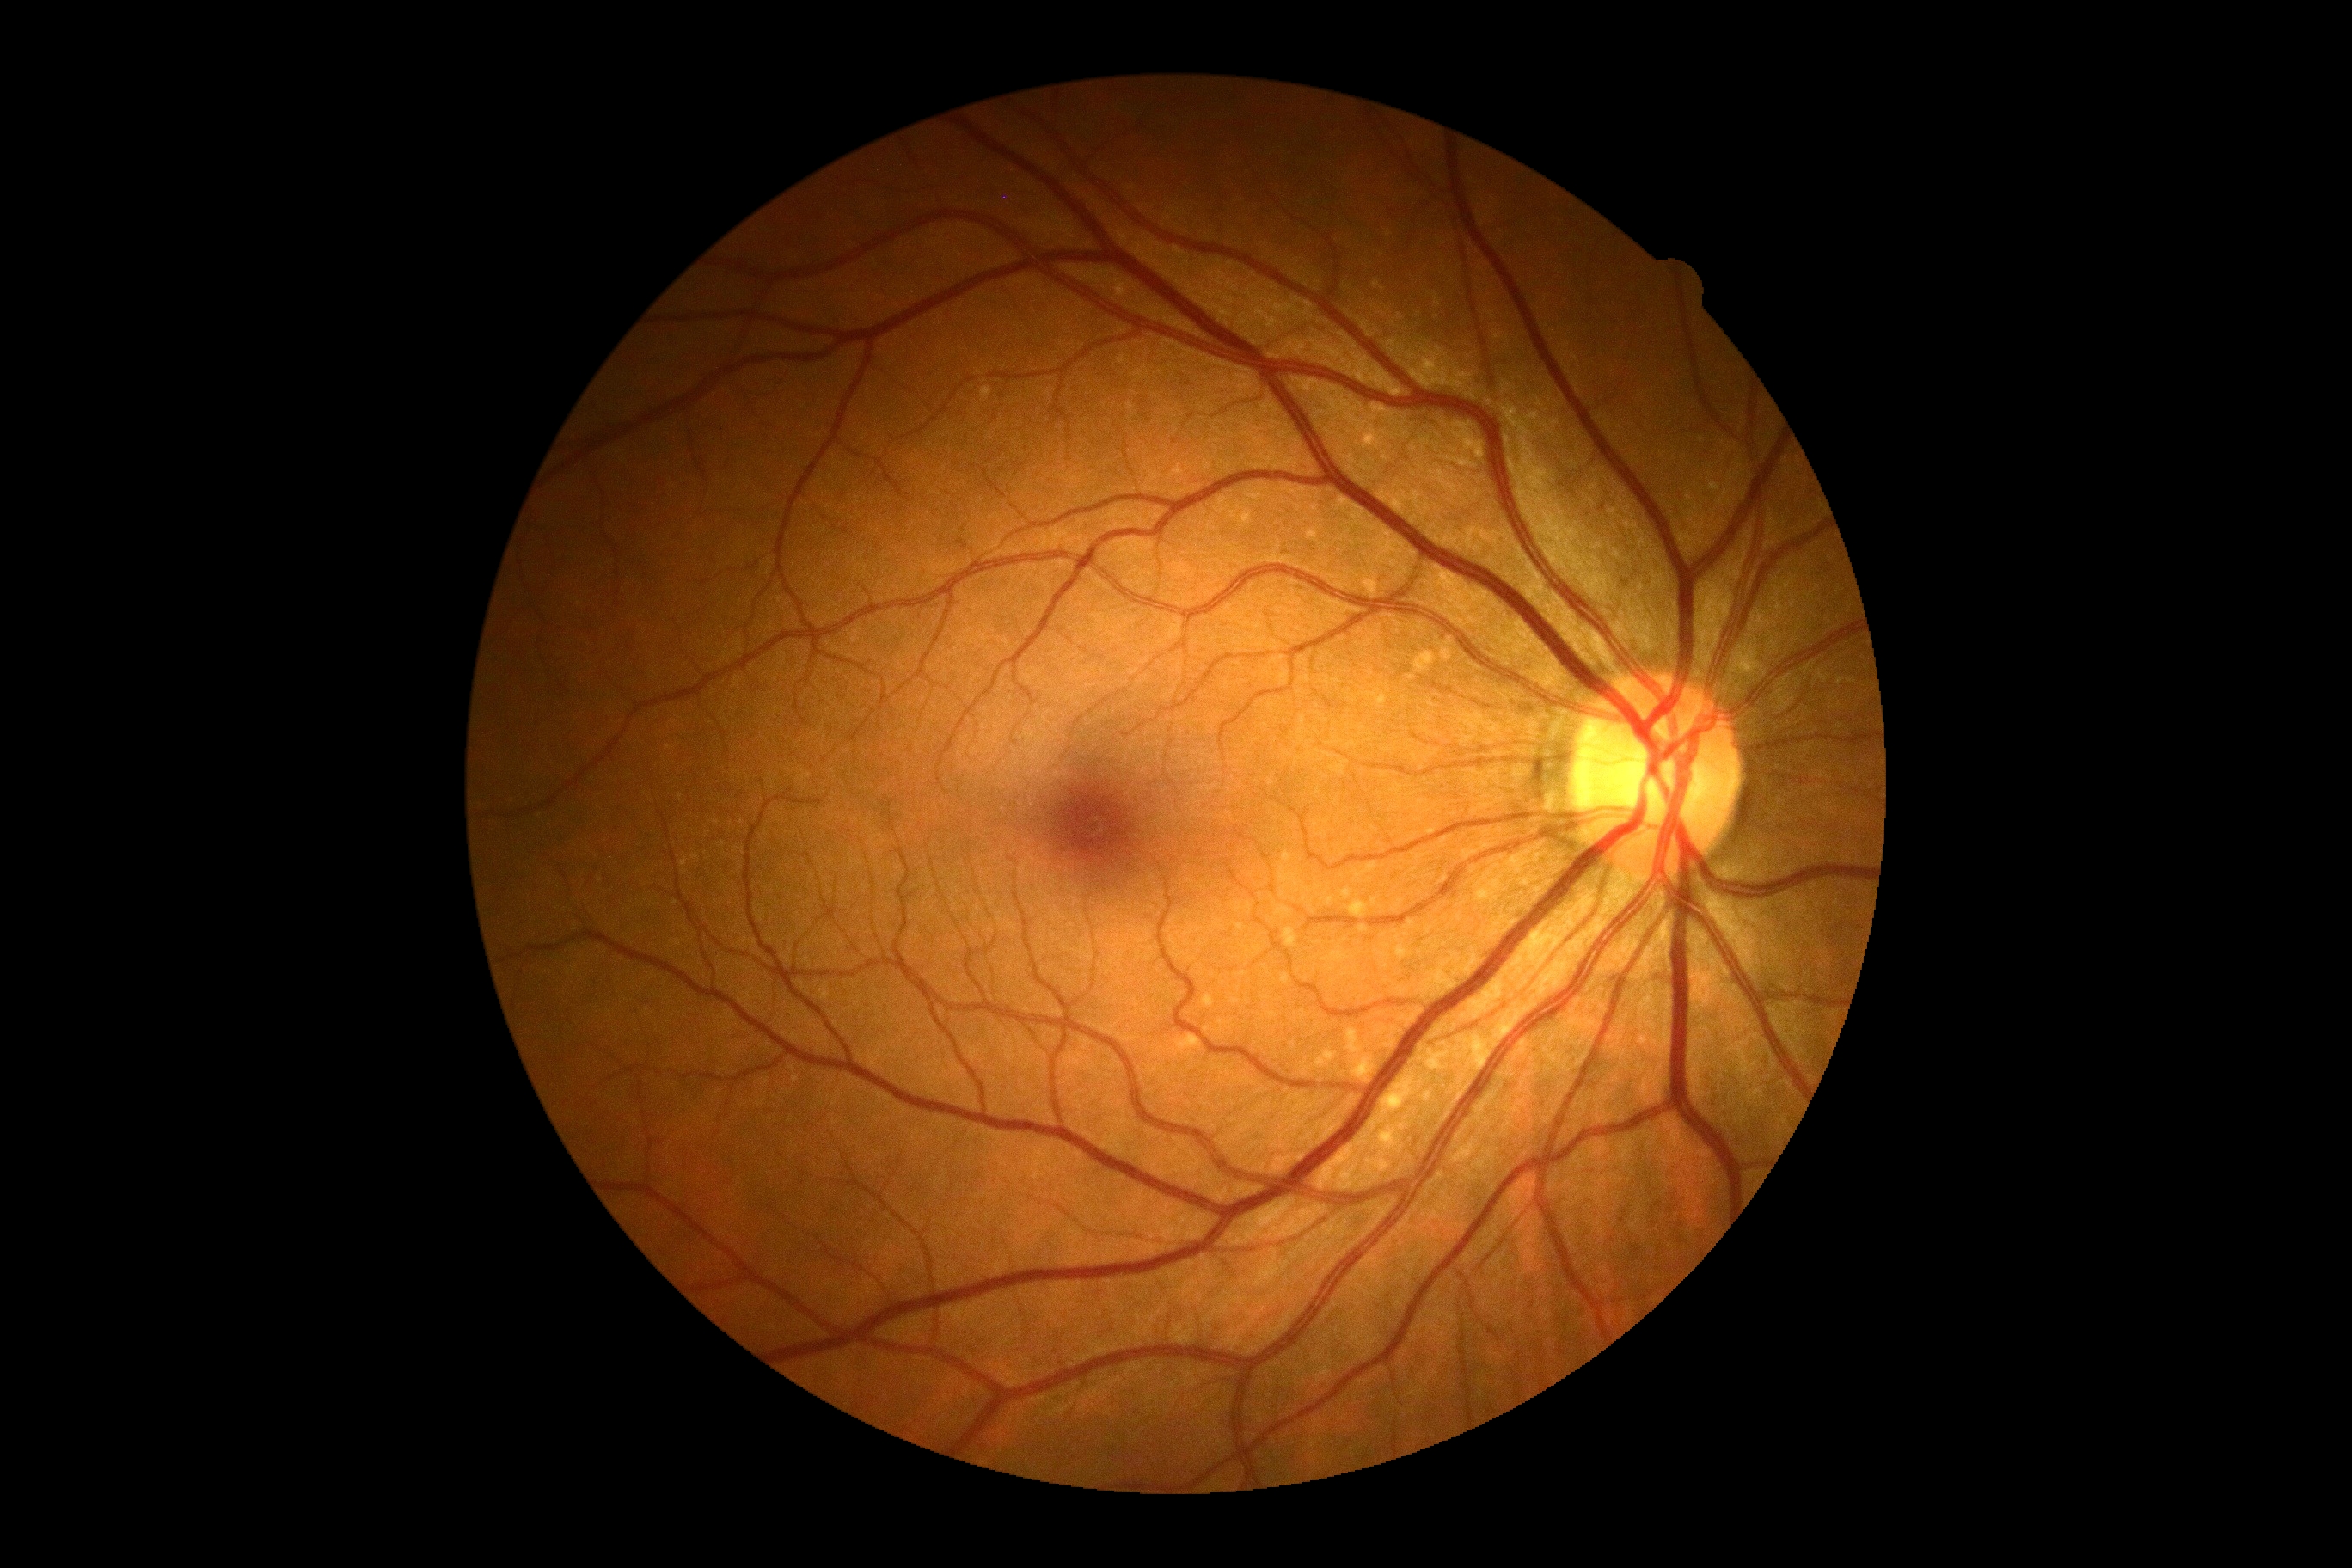 DR grade = no apparent diabetic retinopathy (0) — no visible signs of diabetic retinopathy